848x848px: 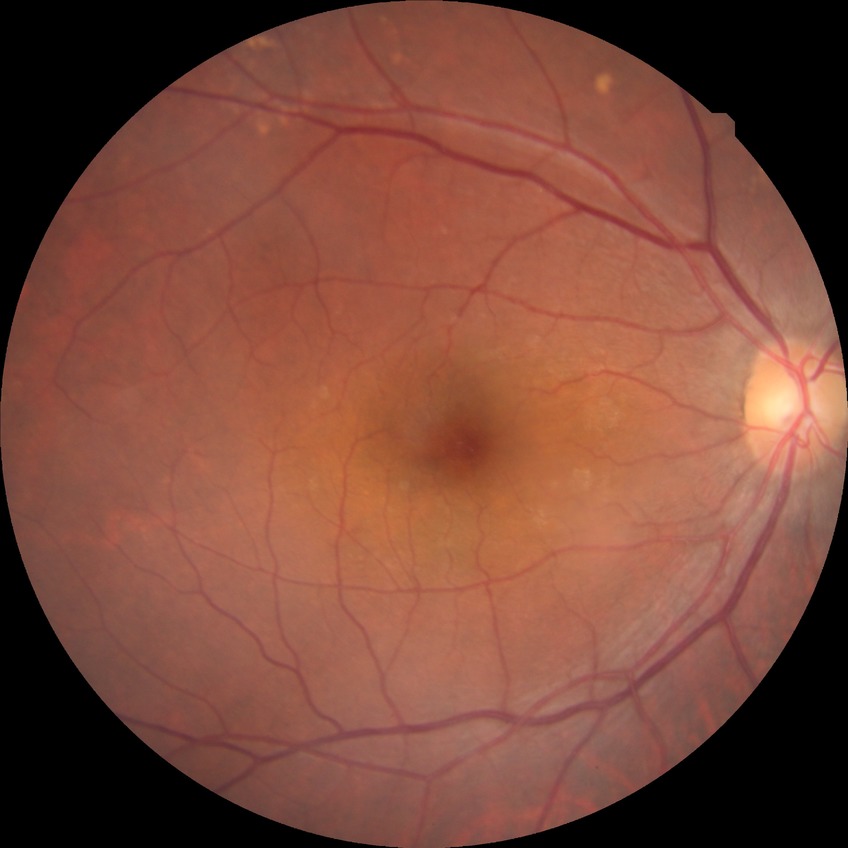

Diabetic retinopathy stage: no diabetic retinopathy.